100° field of view (Phoenix ICON). Wide-field fundus image from infant ROP screening:
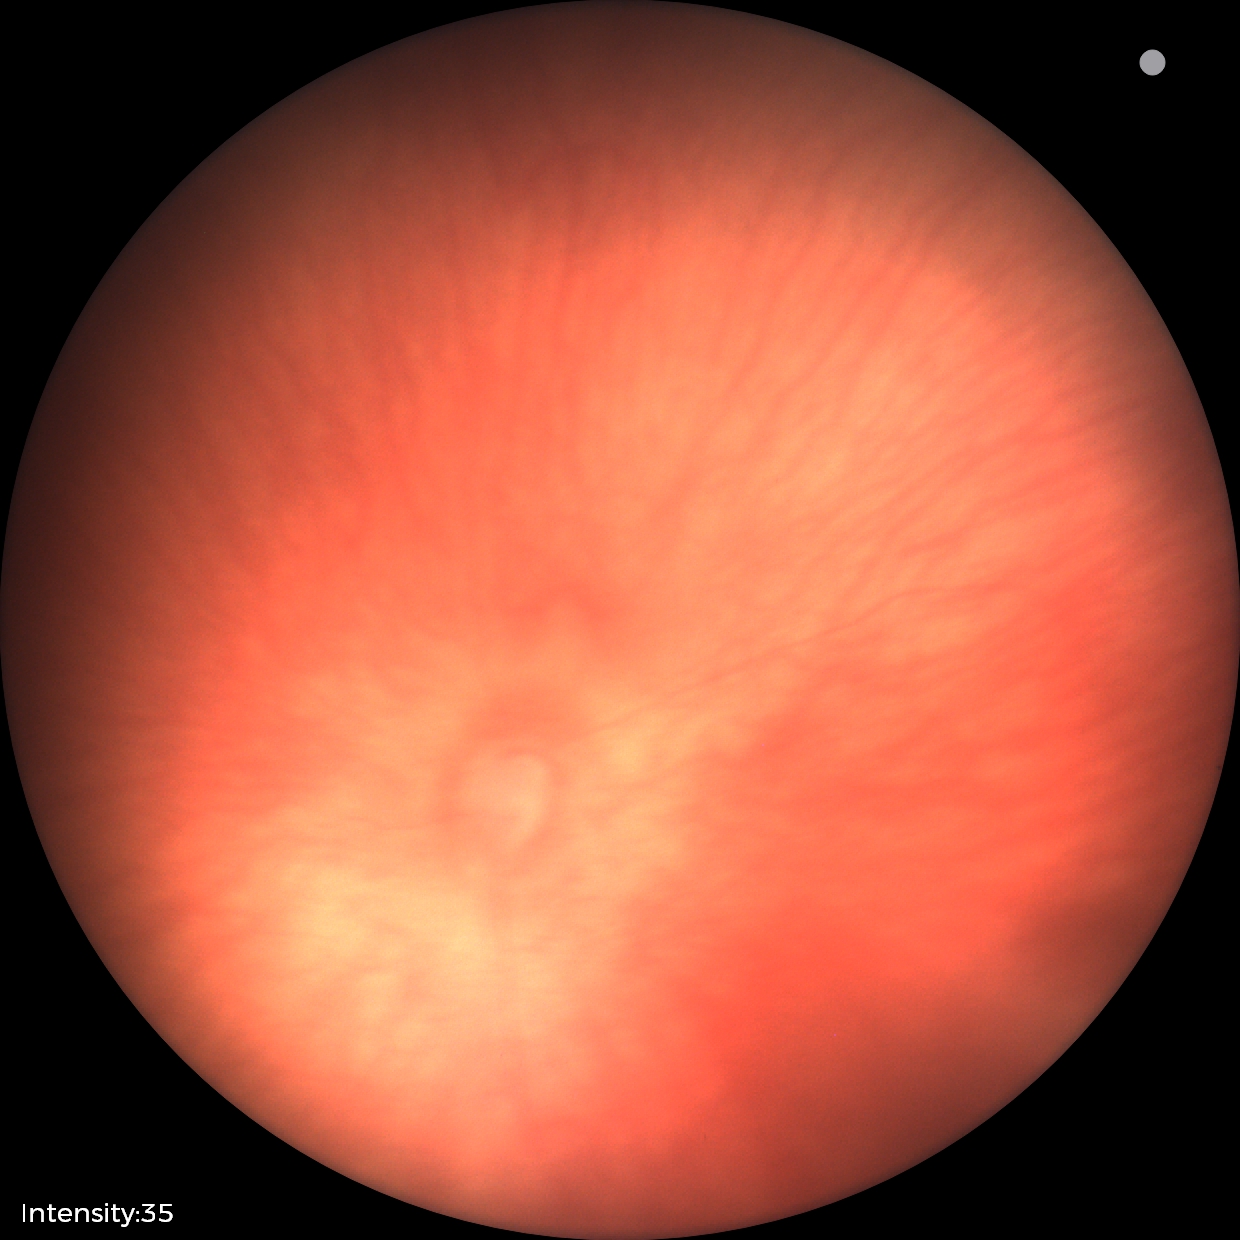 Physiological retinal appearance for postconceptual age.